Infant wide-field retinal image.
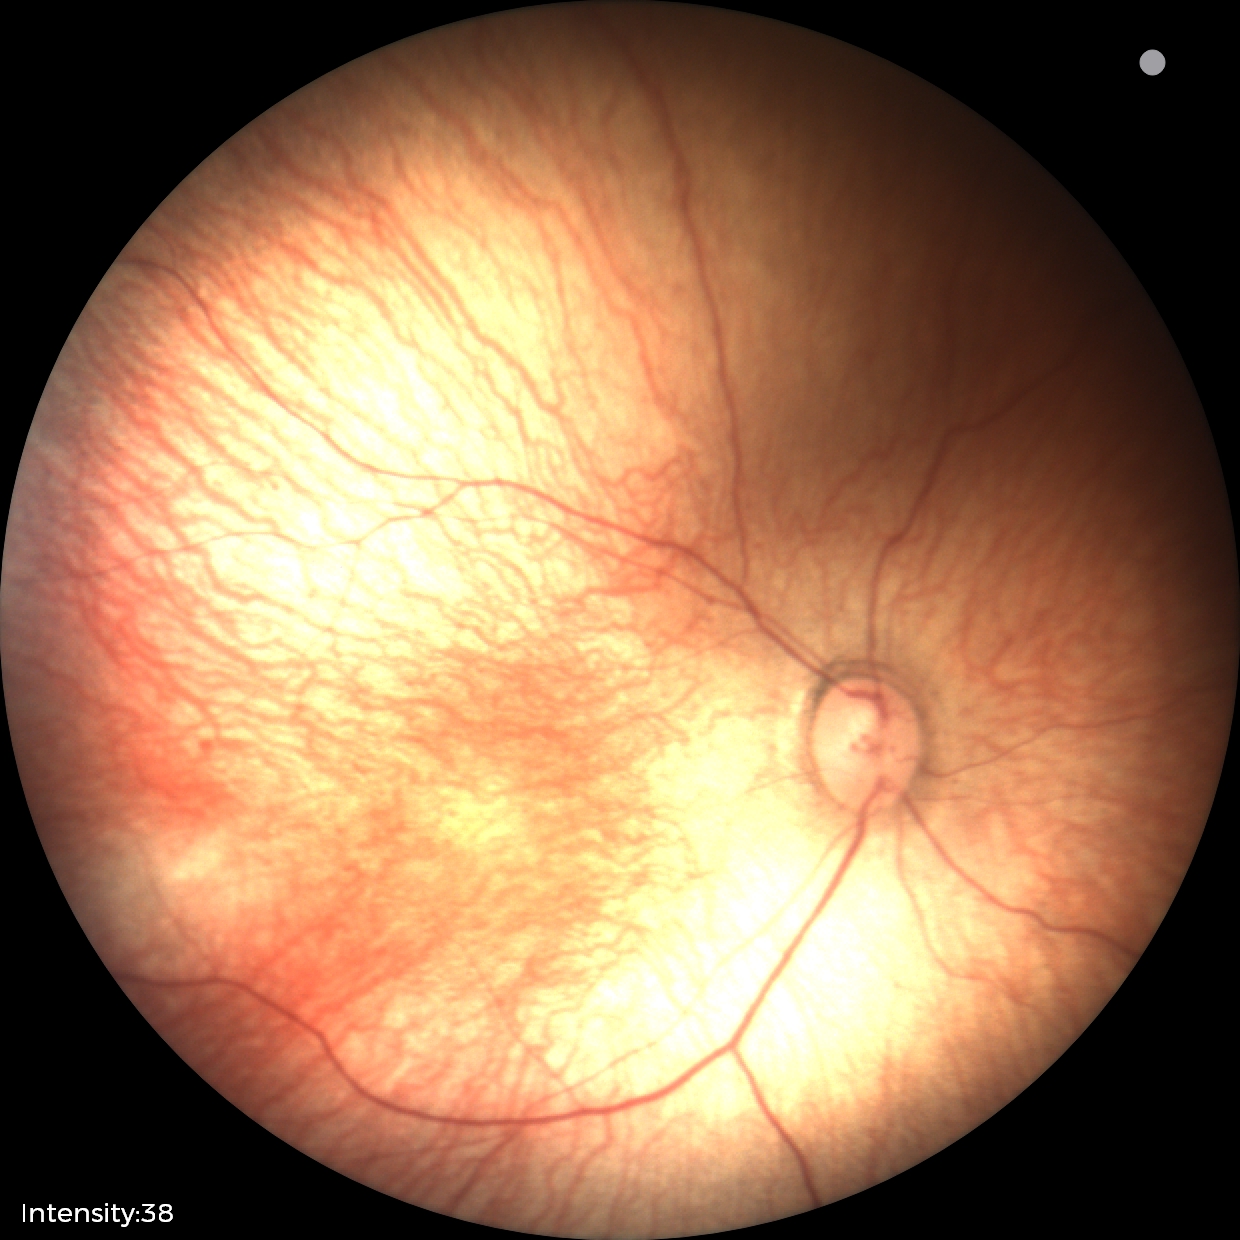

Screening examination with no abnormal retinal findings.